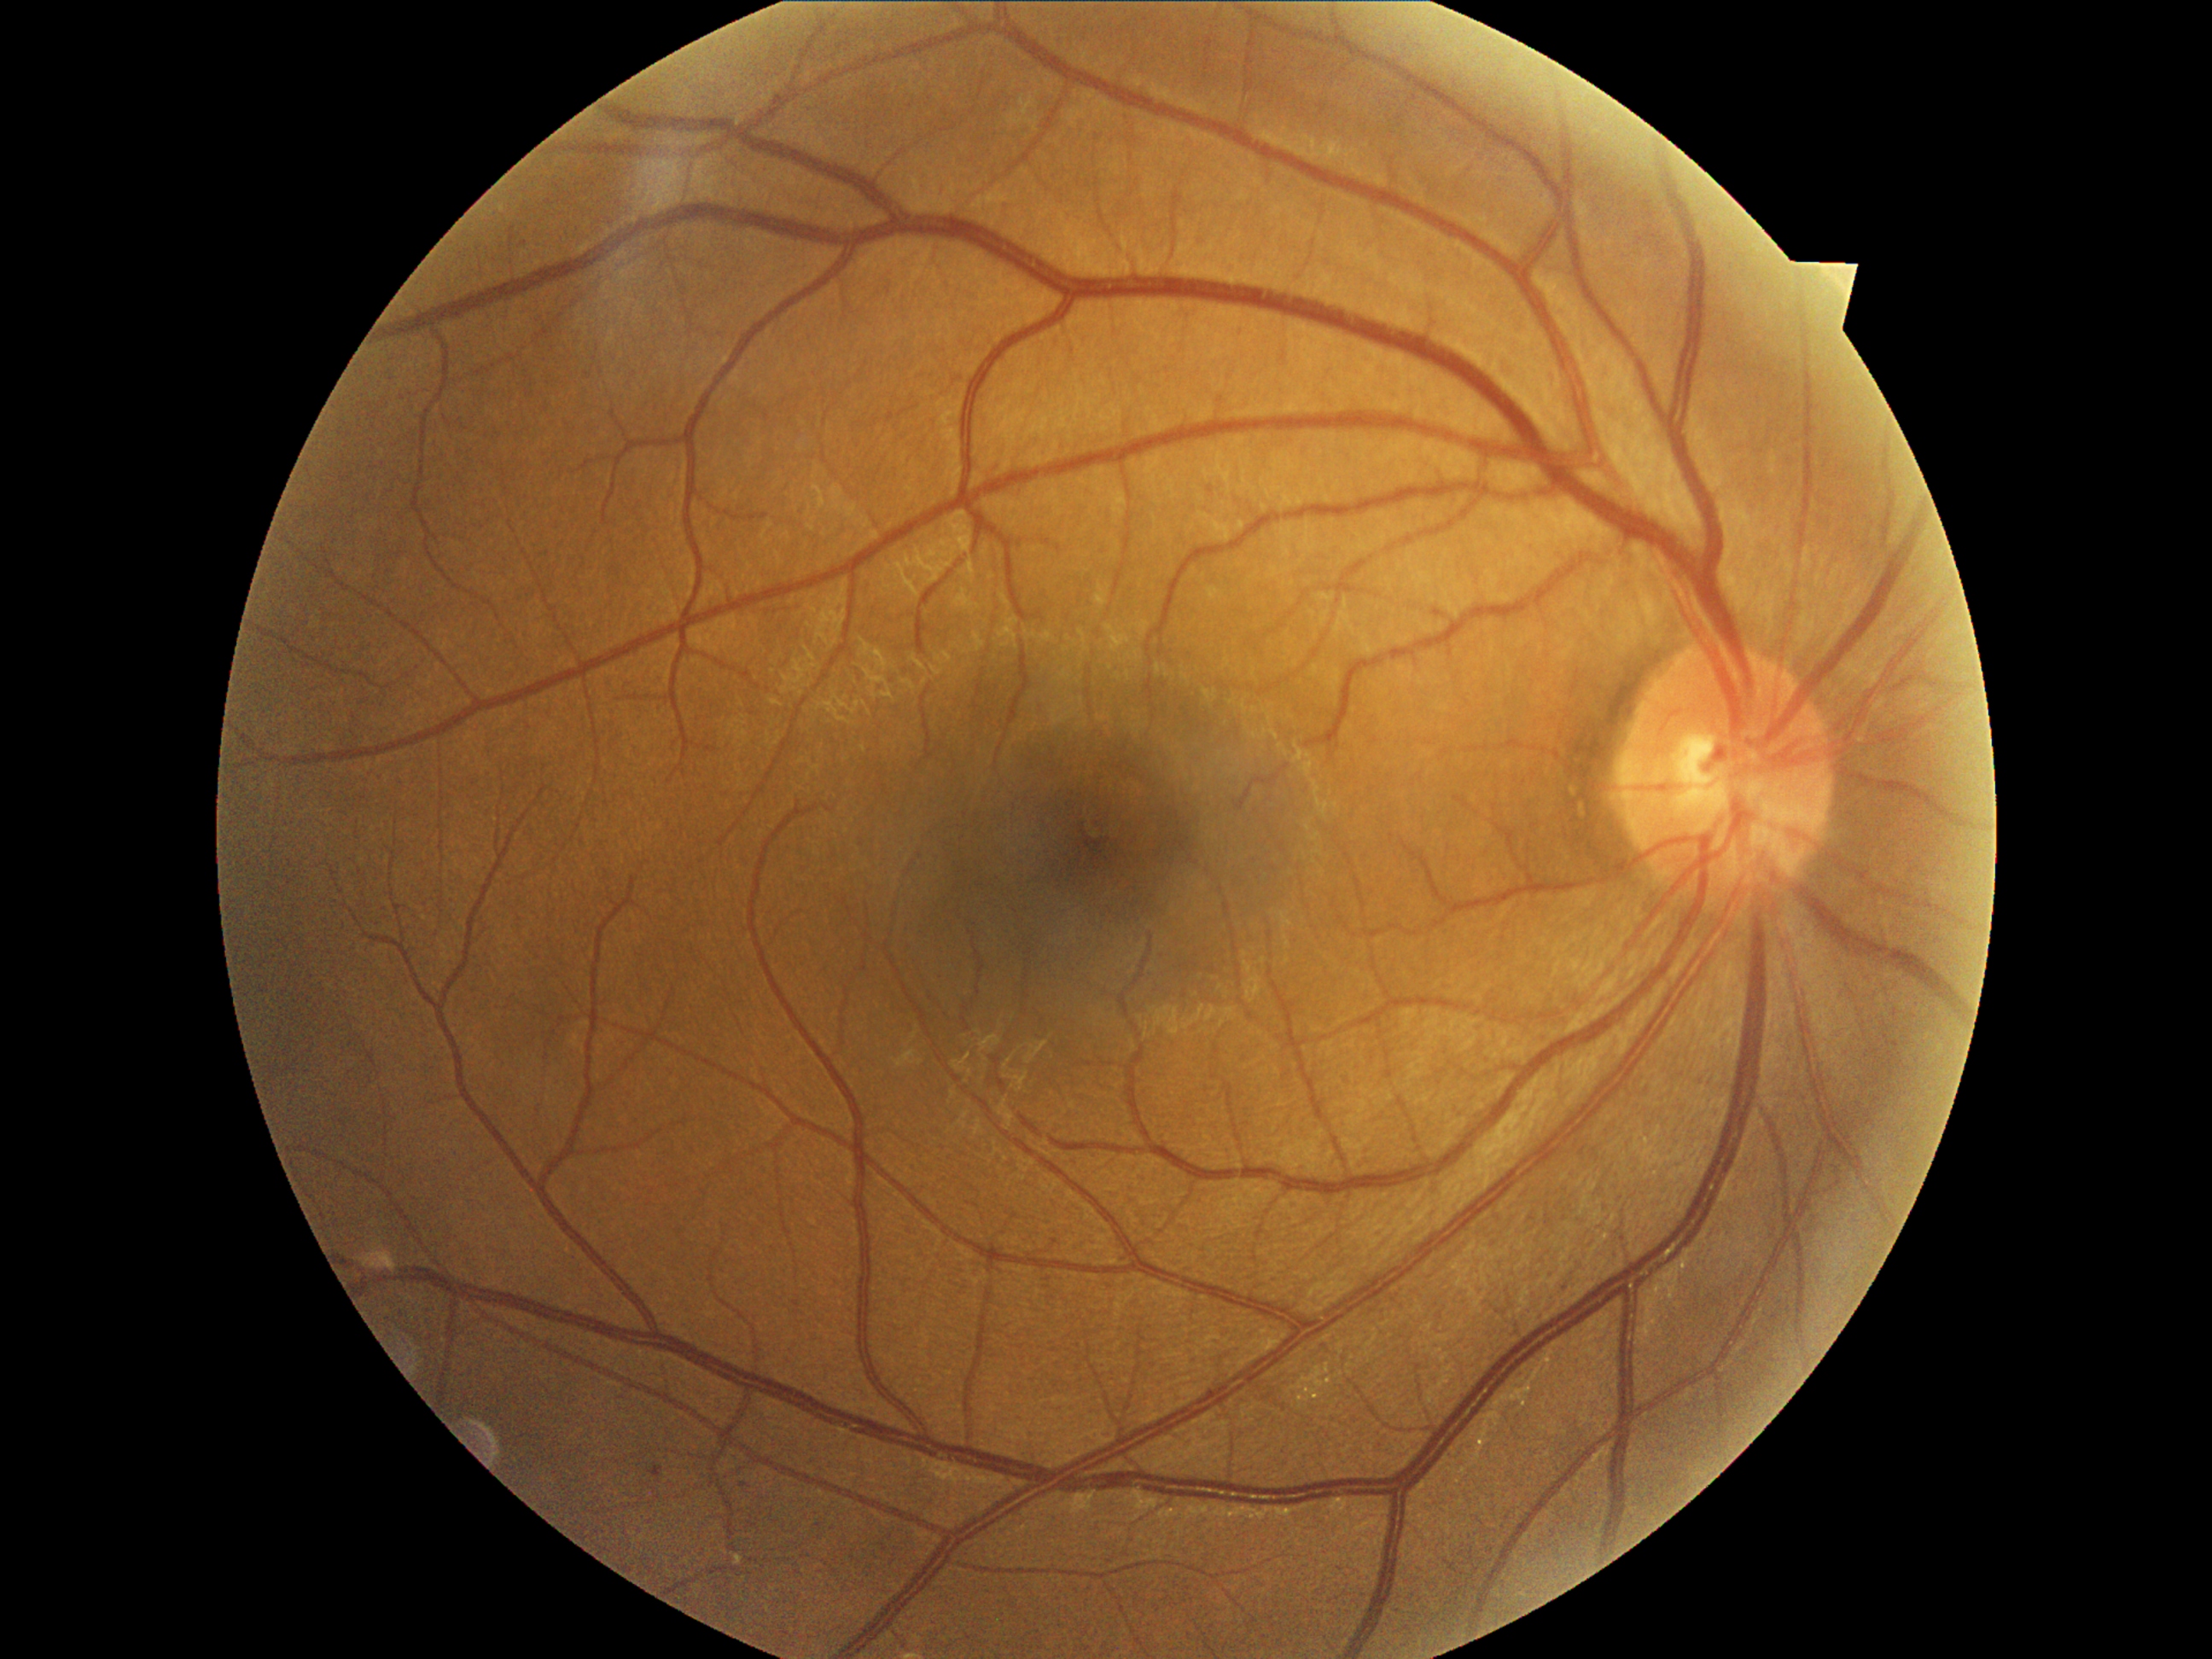
Diabetic retinopathy (DR): mild NPDR (grade 1).